Nonmydriatic fundus photograph. 848x848. Modified Davis classification. Color fundus photograph. Camera: NIDEK AFC-230.
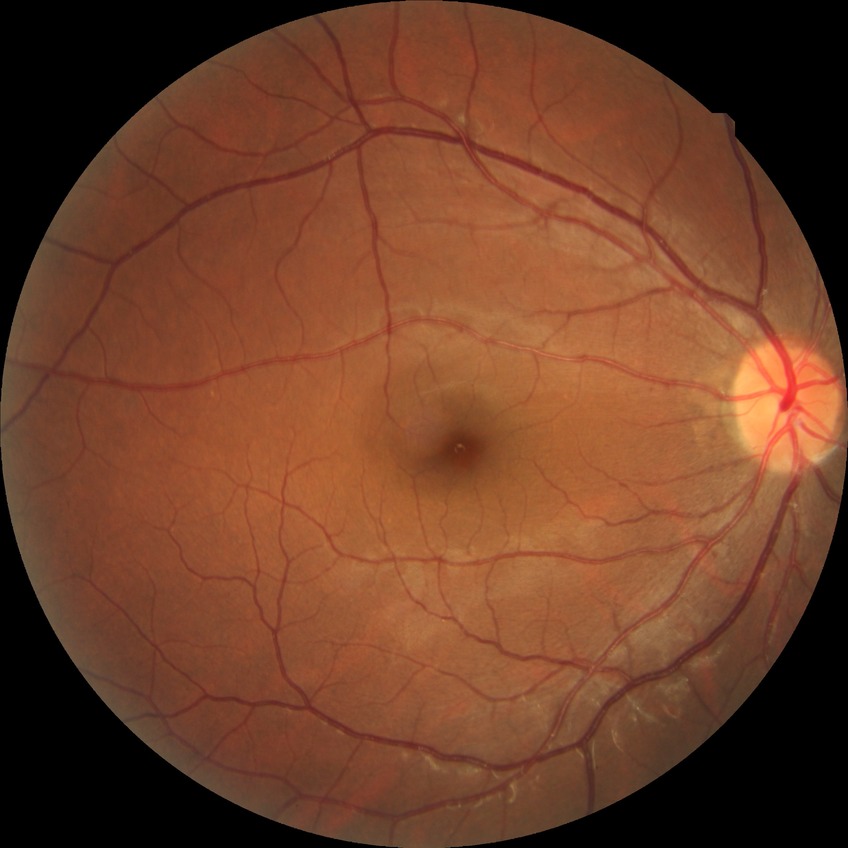
Diabetic retinopathy (DR) is no diabetic retinopathy (NDR).